NIDEK AFC-230 fundus camera — 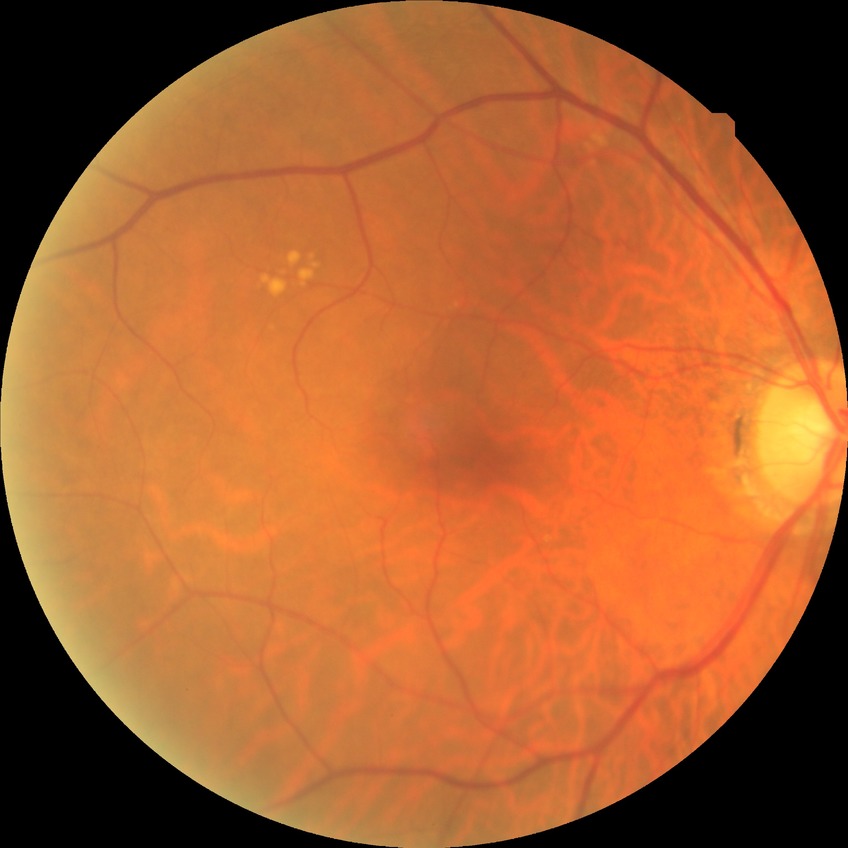 Diabetic retinopathy (DR): NDR (no diabetic retinopathy).